45-degree field of view · CFP:
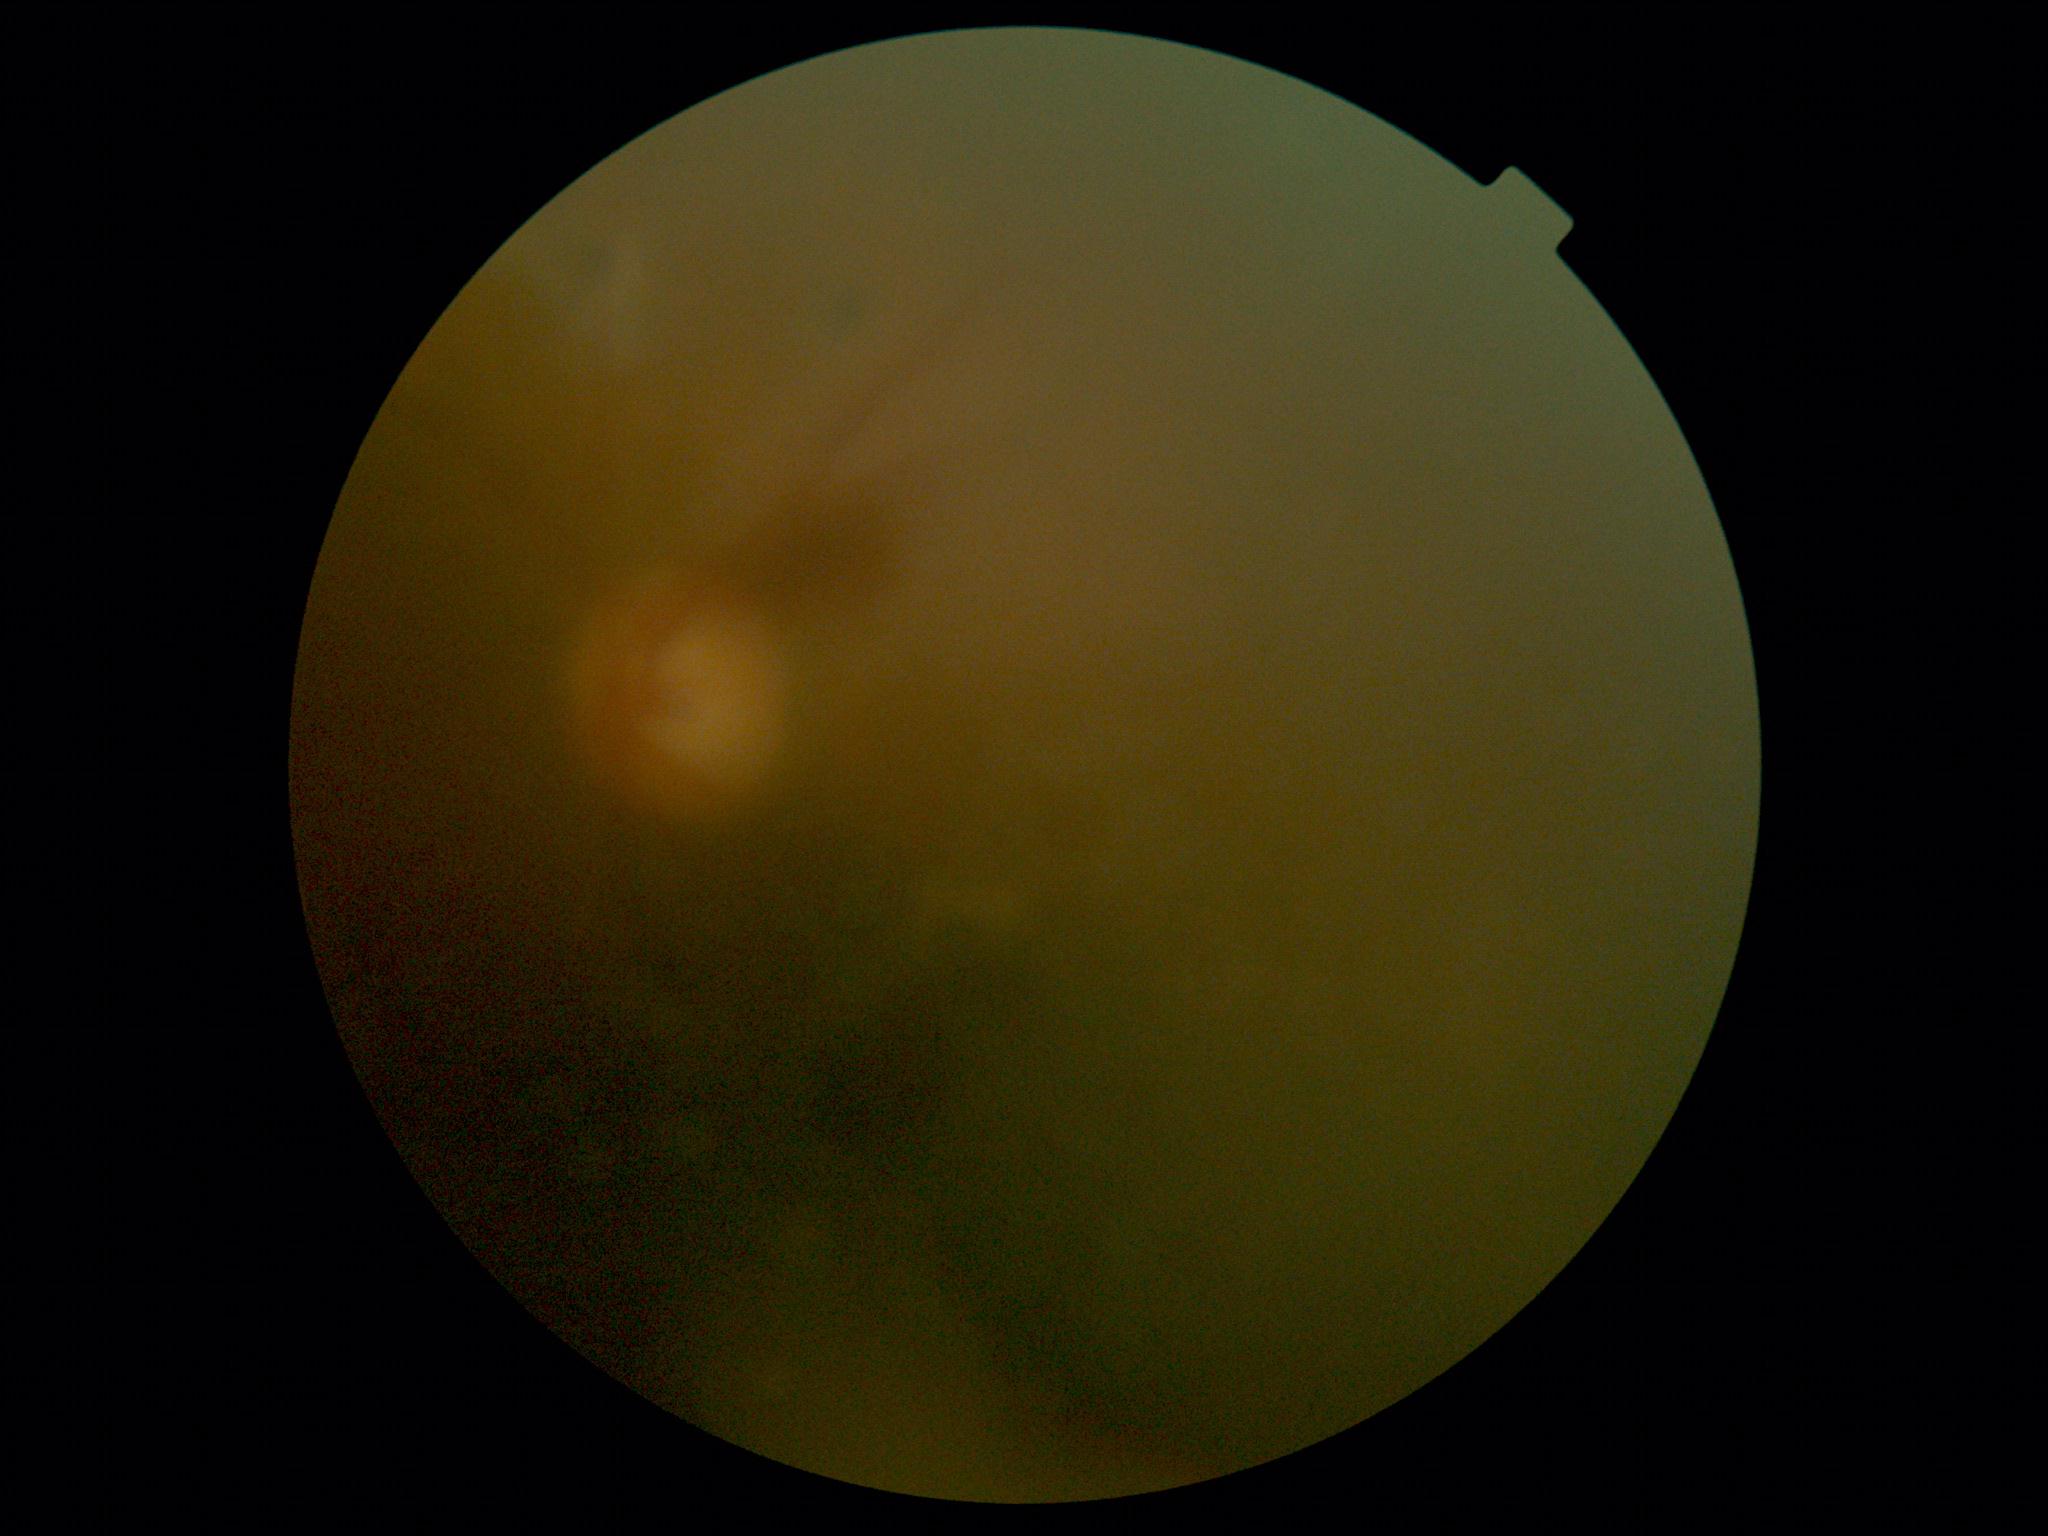

DR stage: ungradable. The image cannot be graded for diabetic retinopathy.